200° field of view: 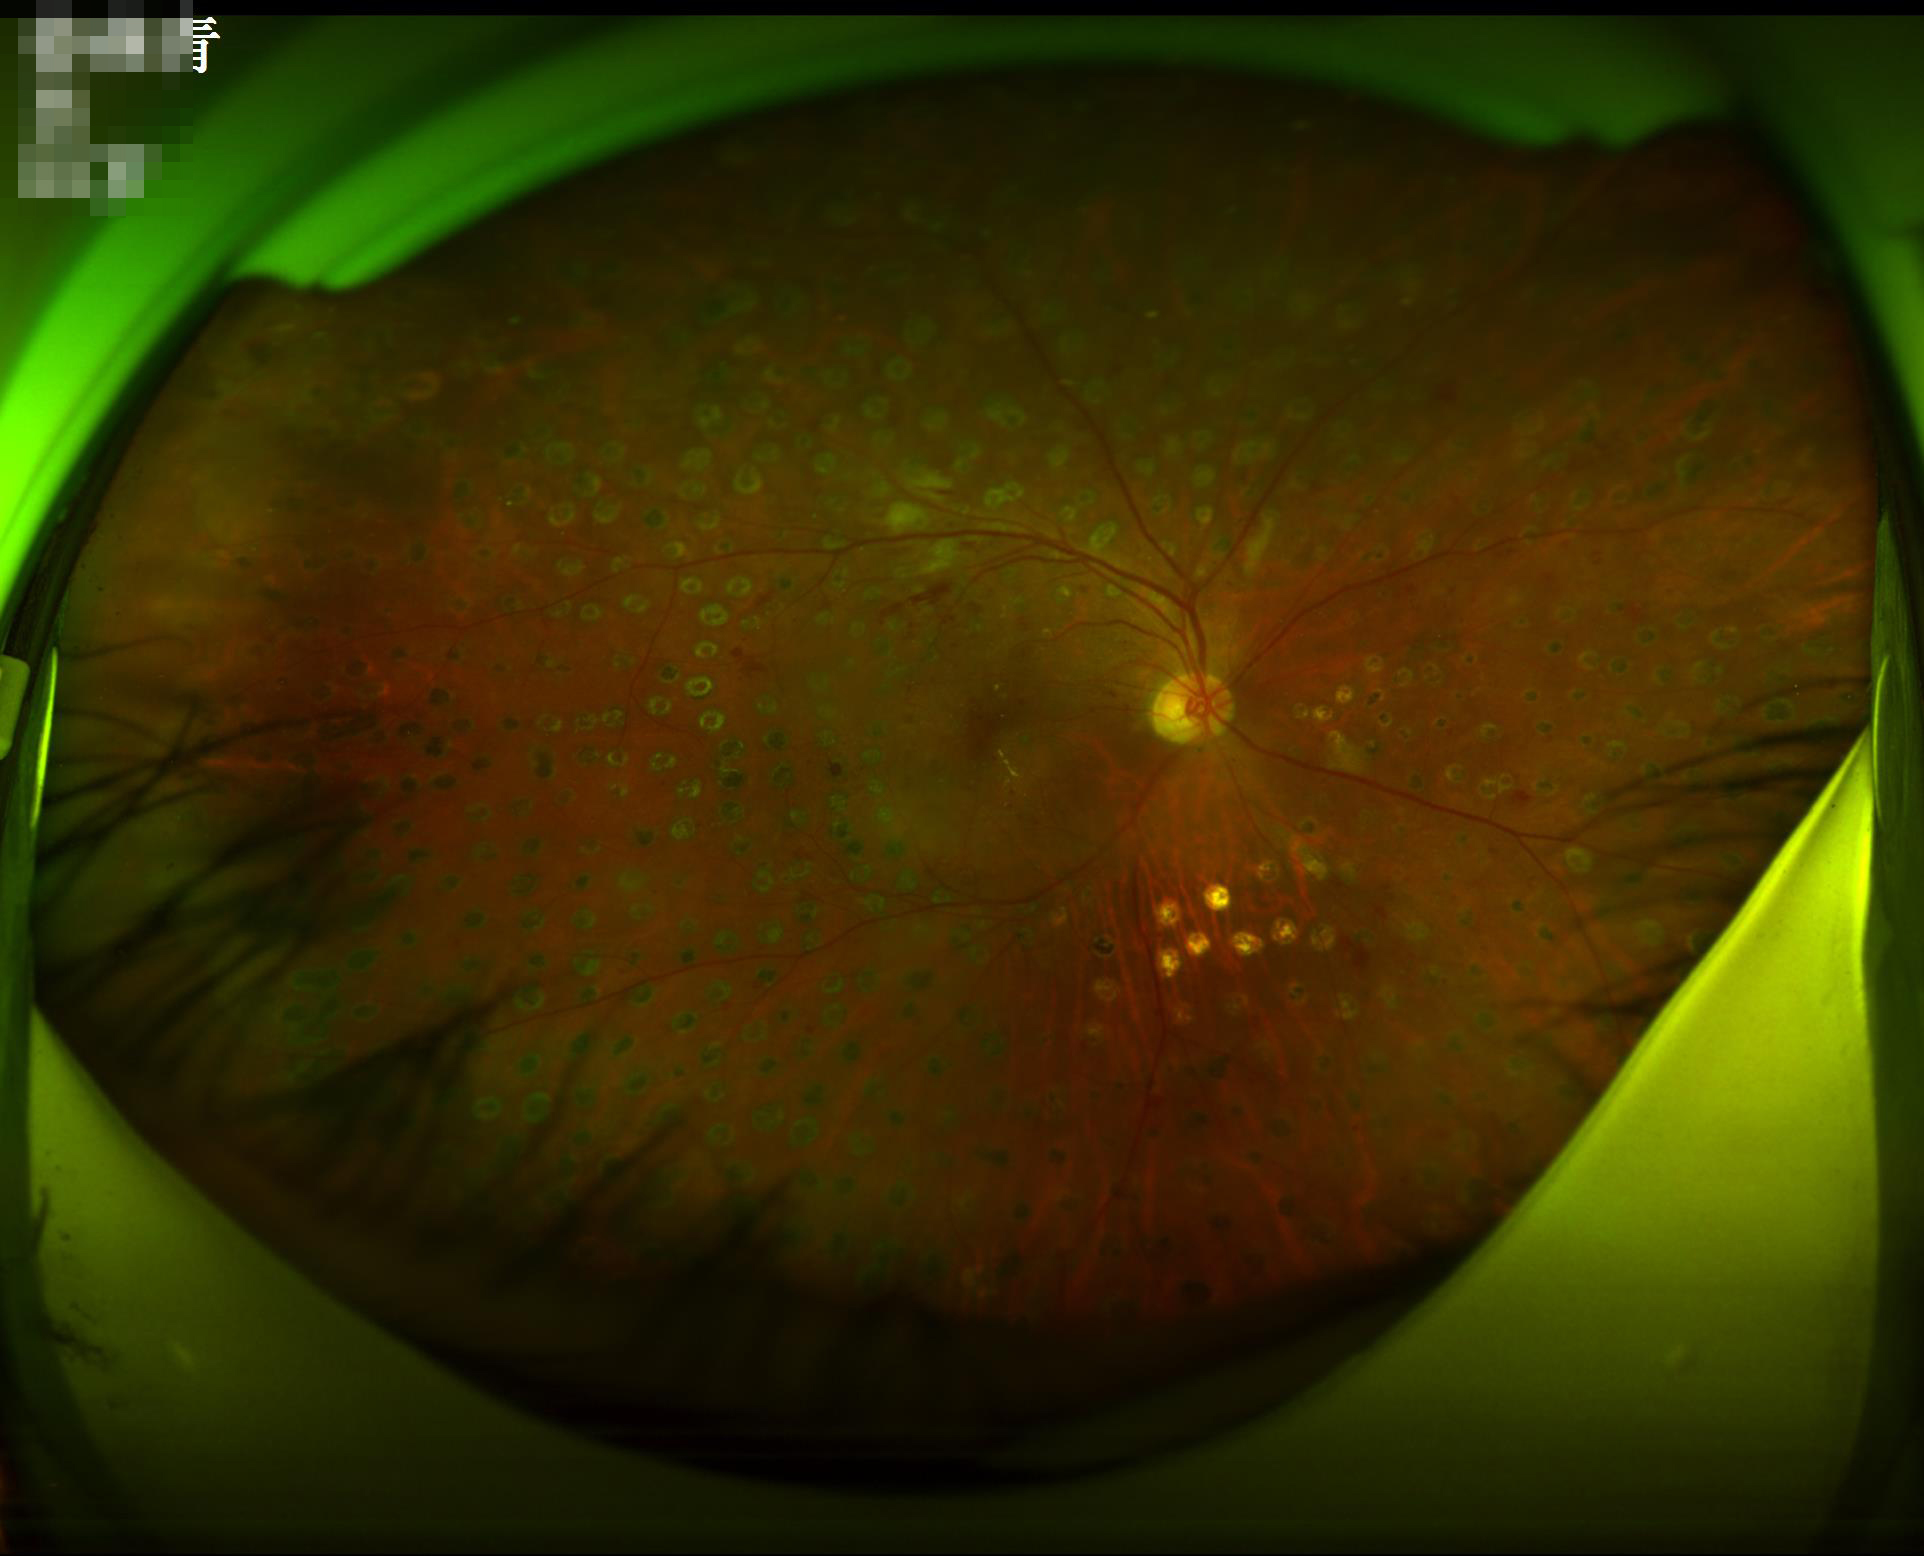
contrast: wide intensity range, structures distinguishable
clarity: optic disc, vessels, and background in focus
overall_quality: good, gradable
illumination: over- or under-exposed